45° FOV; color fundus image; no pharmacologic dilation; image size 848x848 — 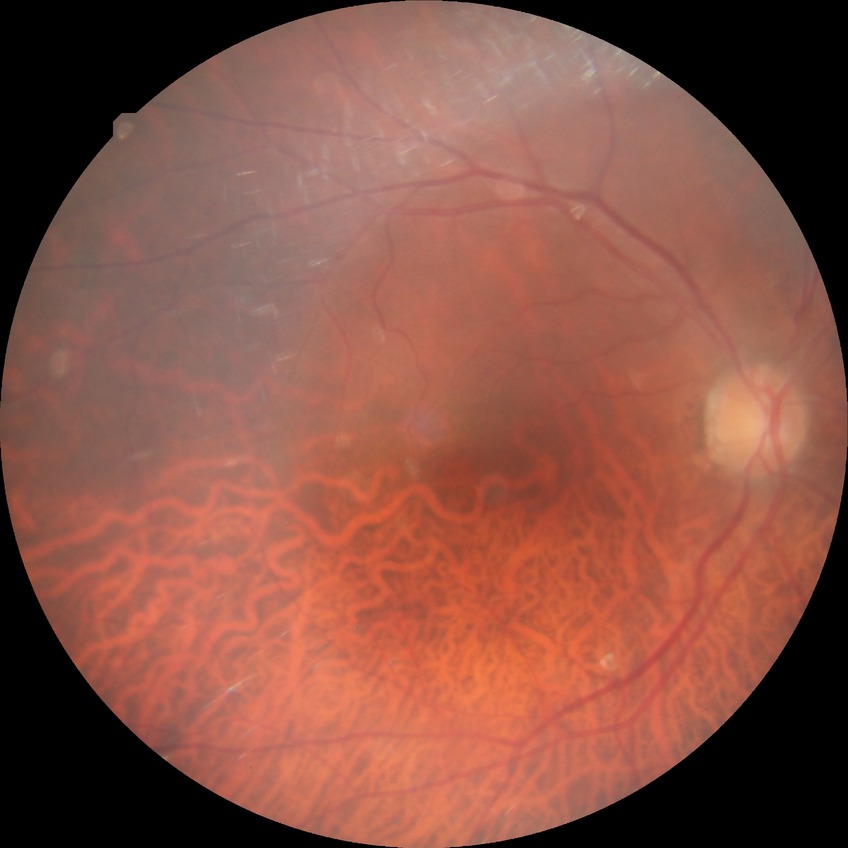

diabetic retinopathy severity = no diabetic retinopathy.